2048 by 1536 pixels. Fundus photo
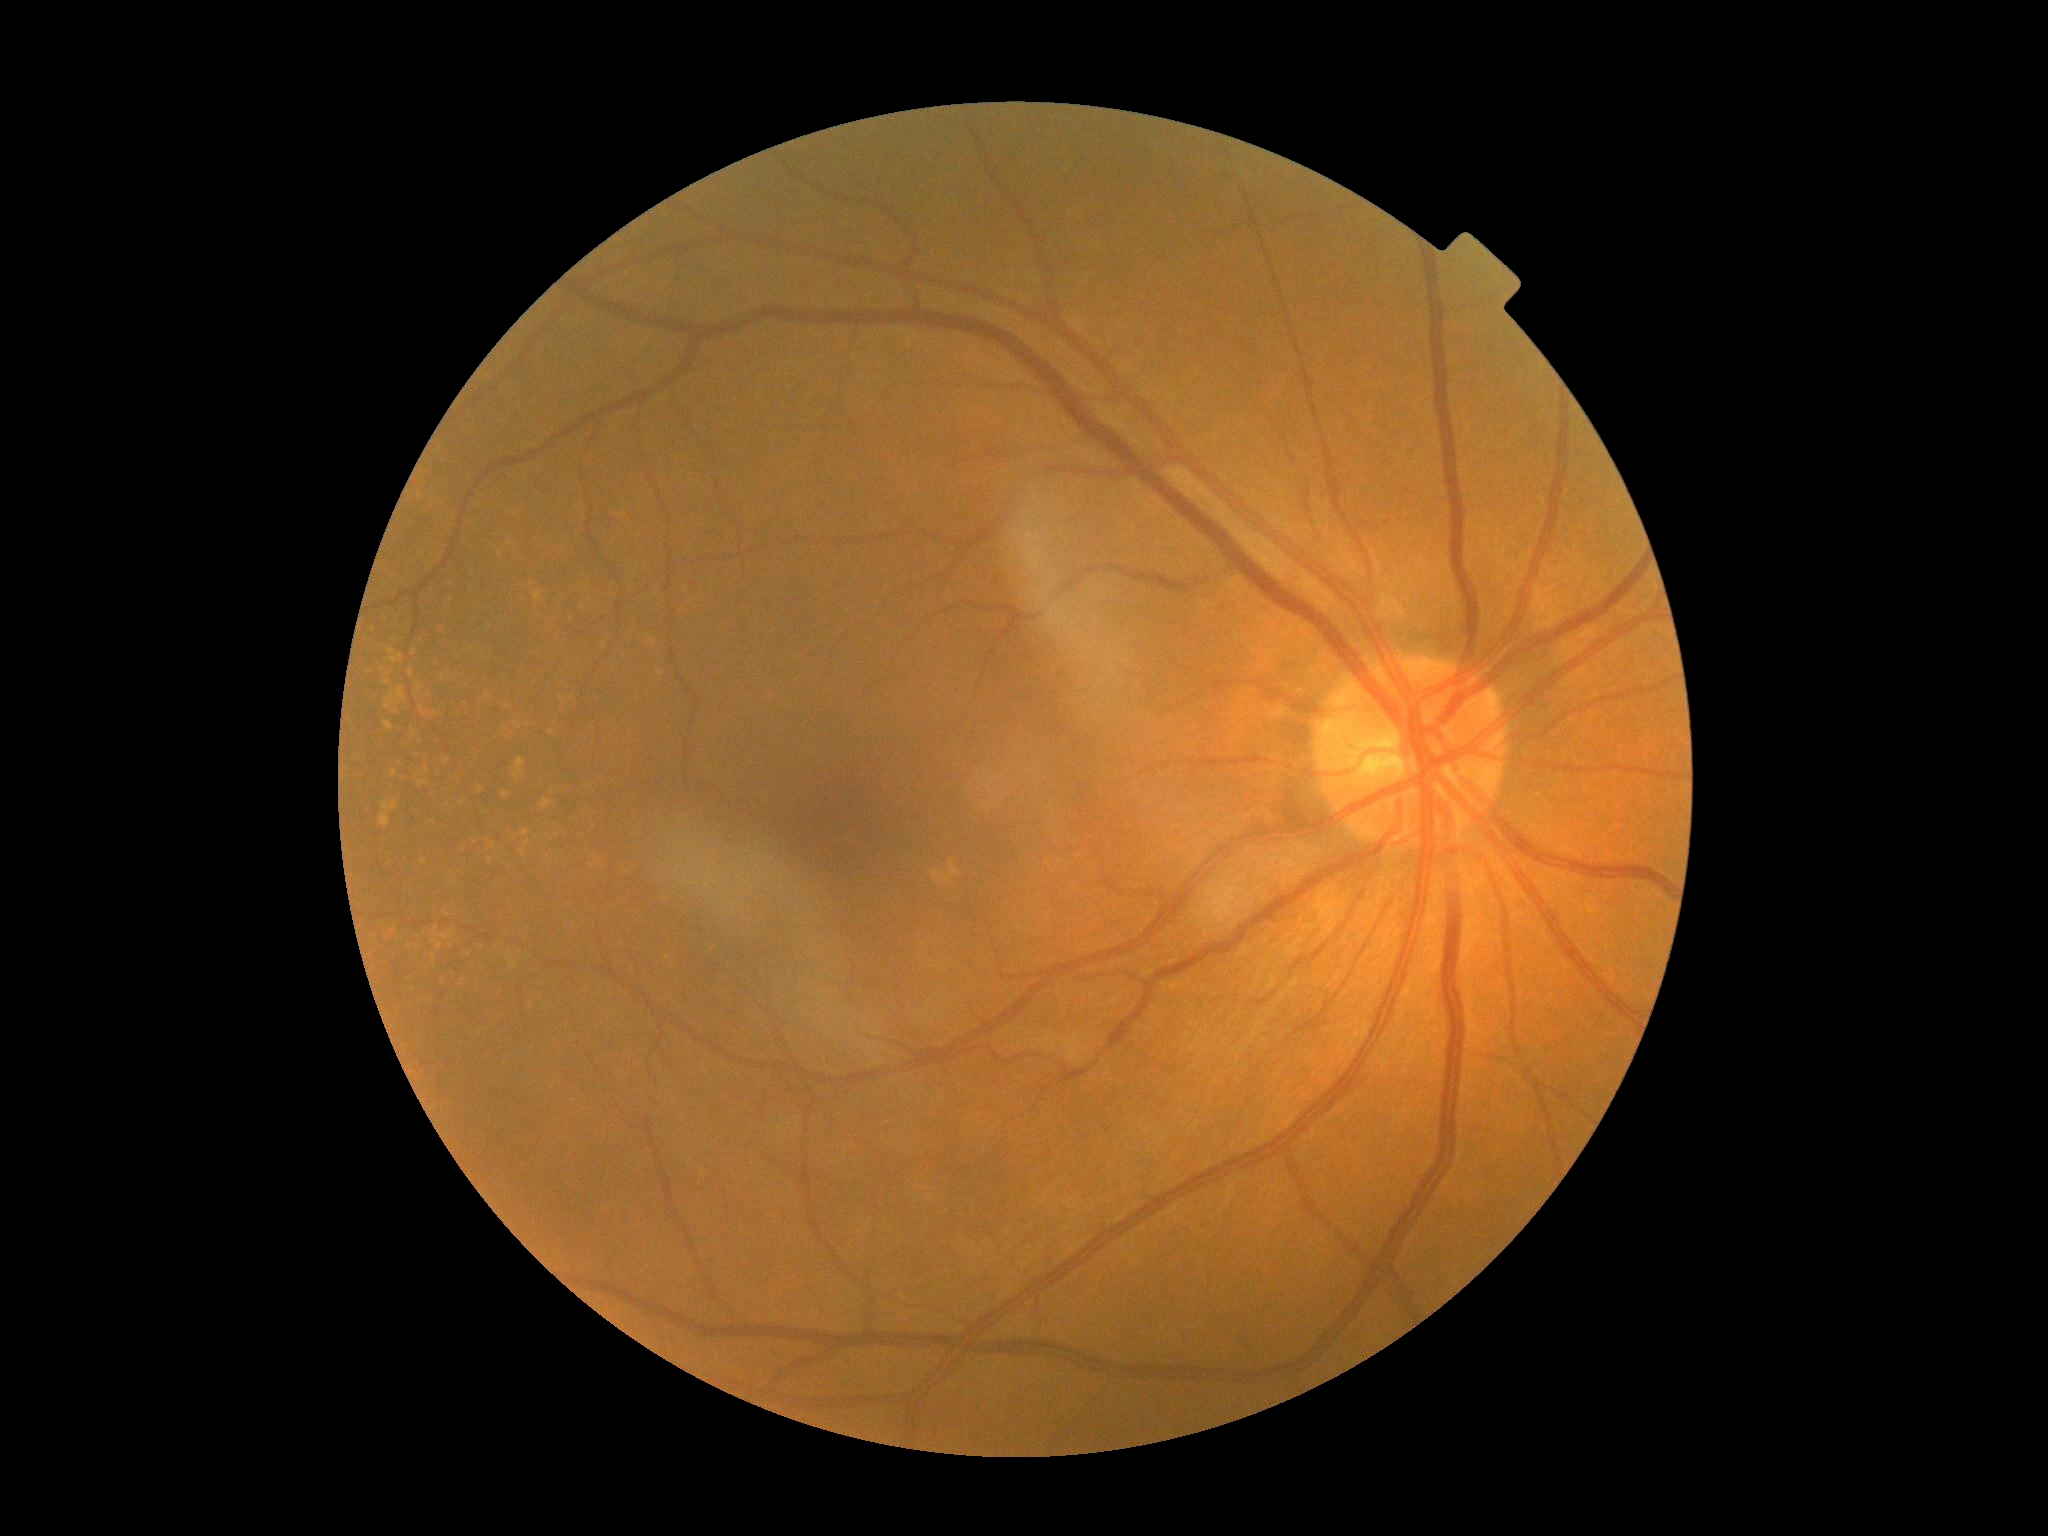
DR: 0/4.